45-degree field of view — 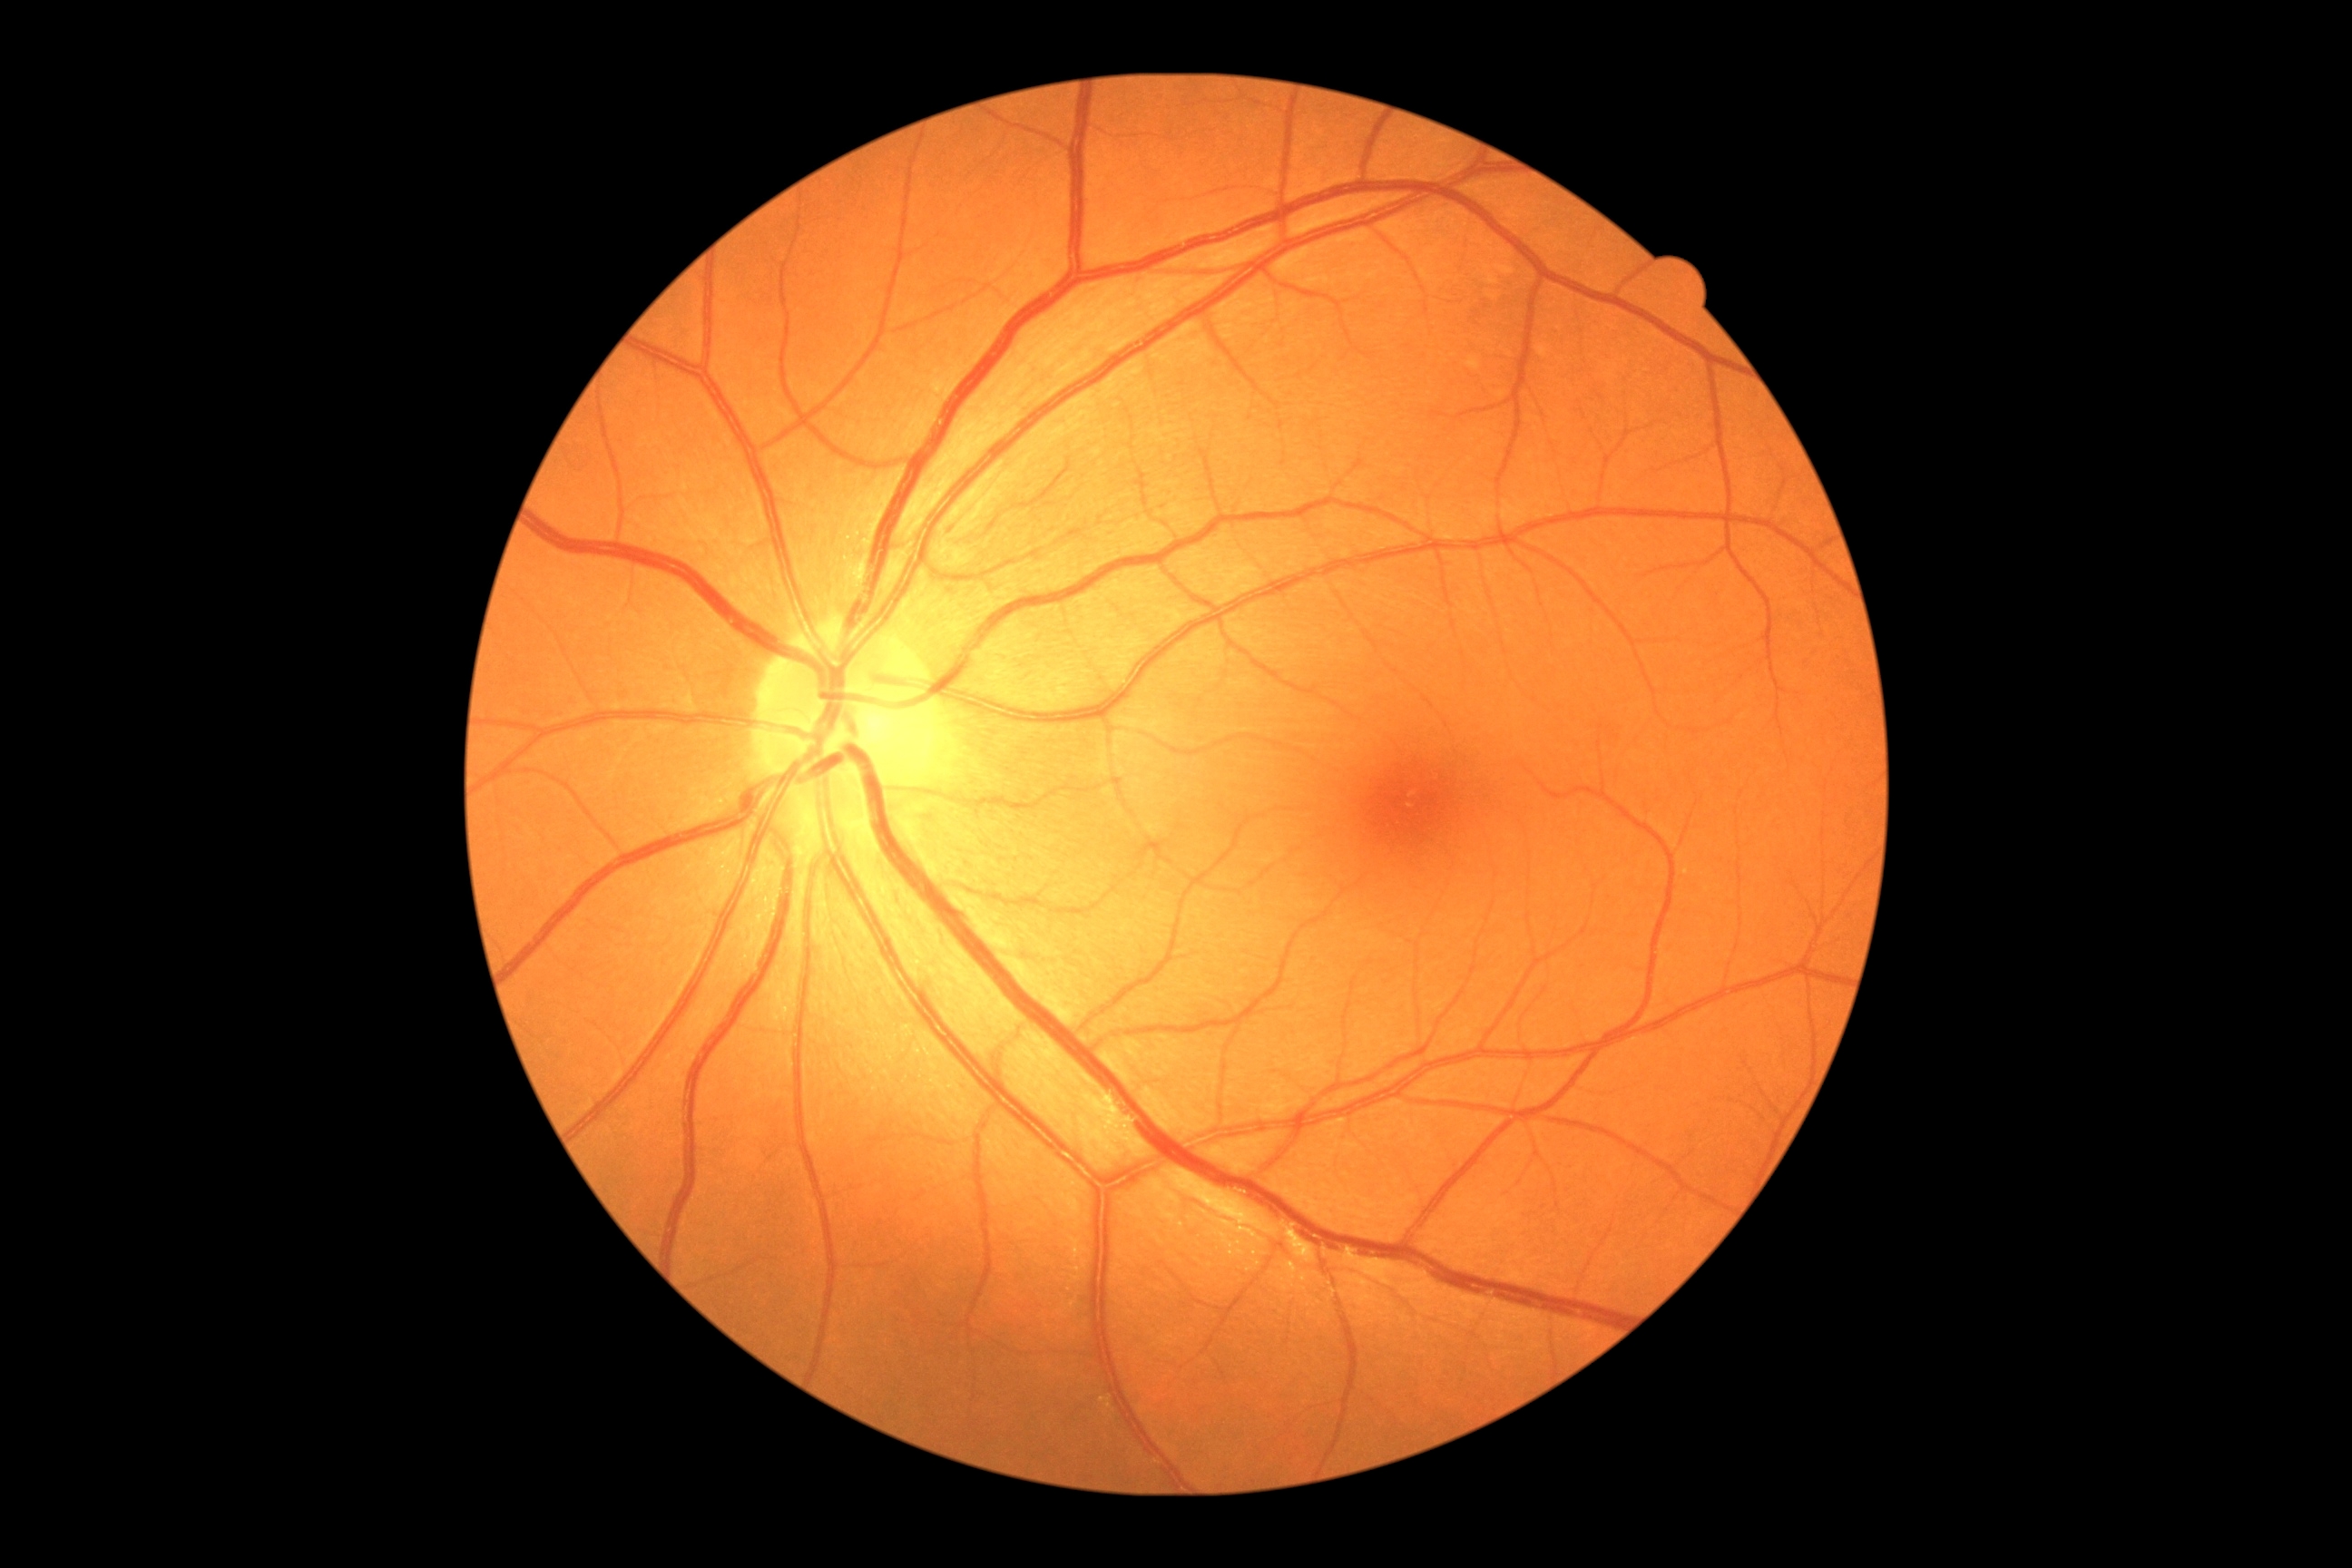
No signs of diabetic retinopathy.
Diabetic retinopathy: no apparent diabetic retinopathy (grade 0).